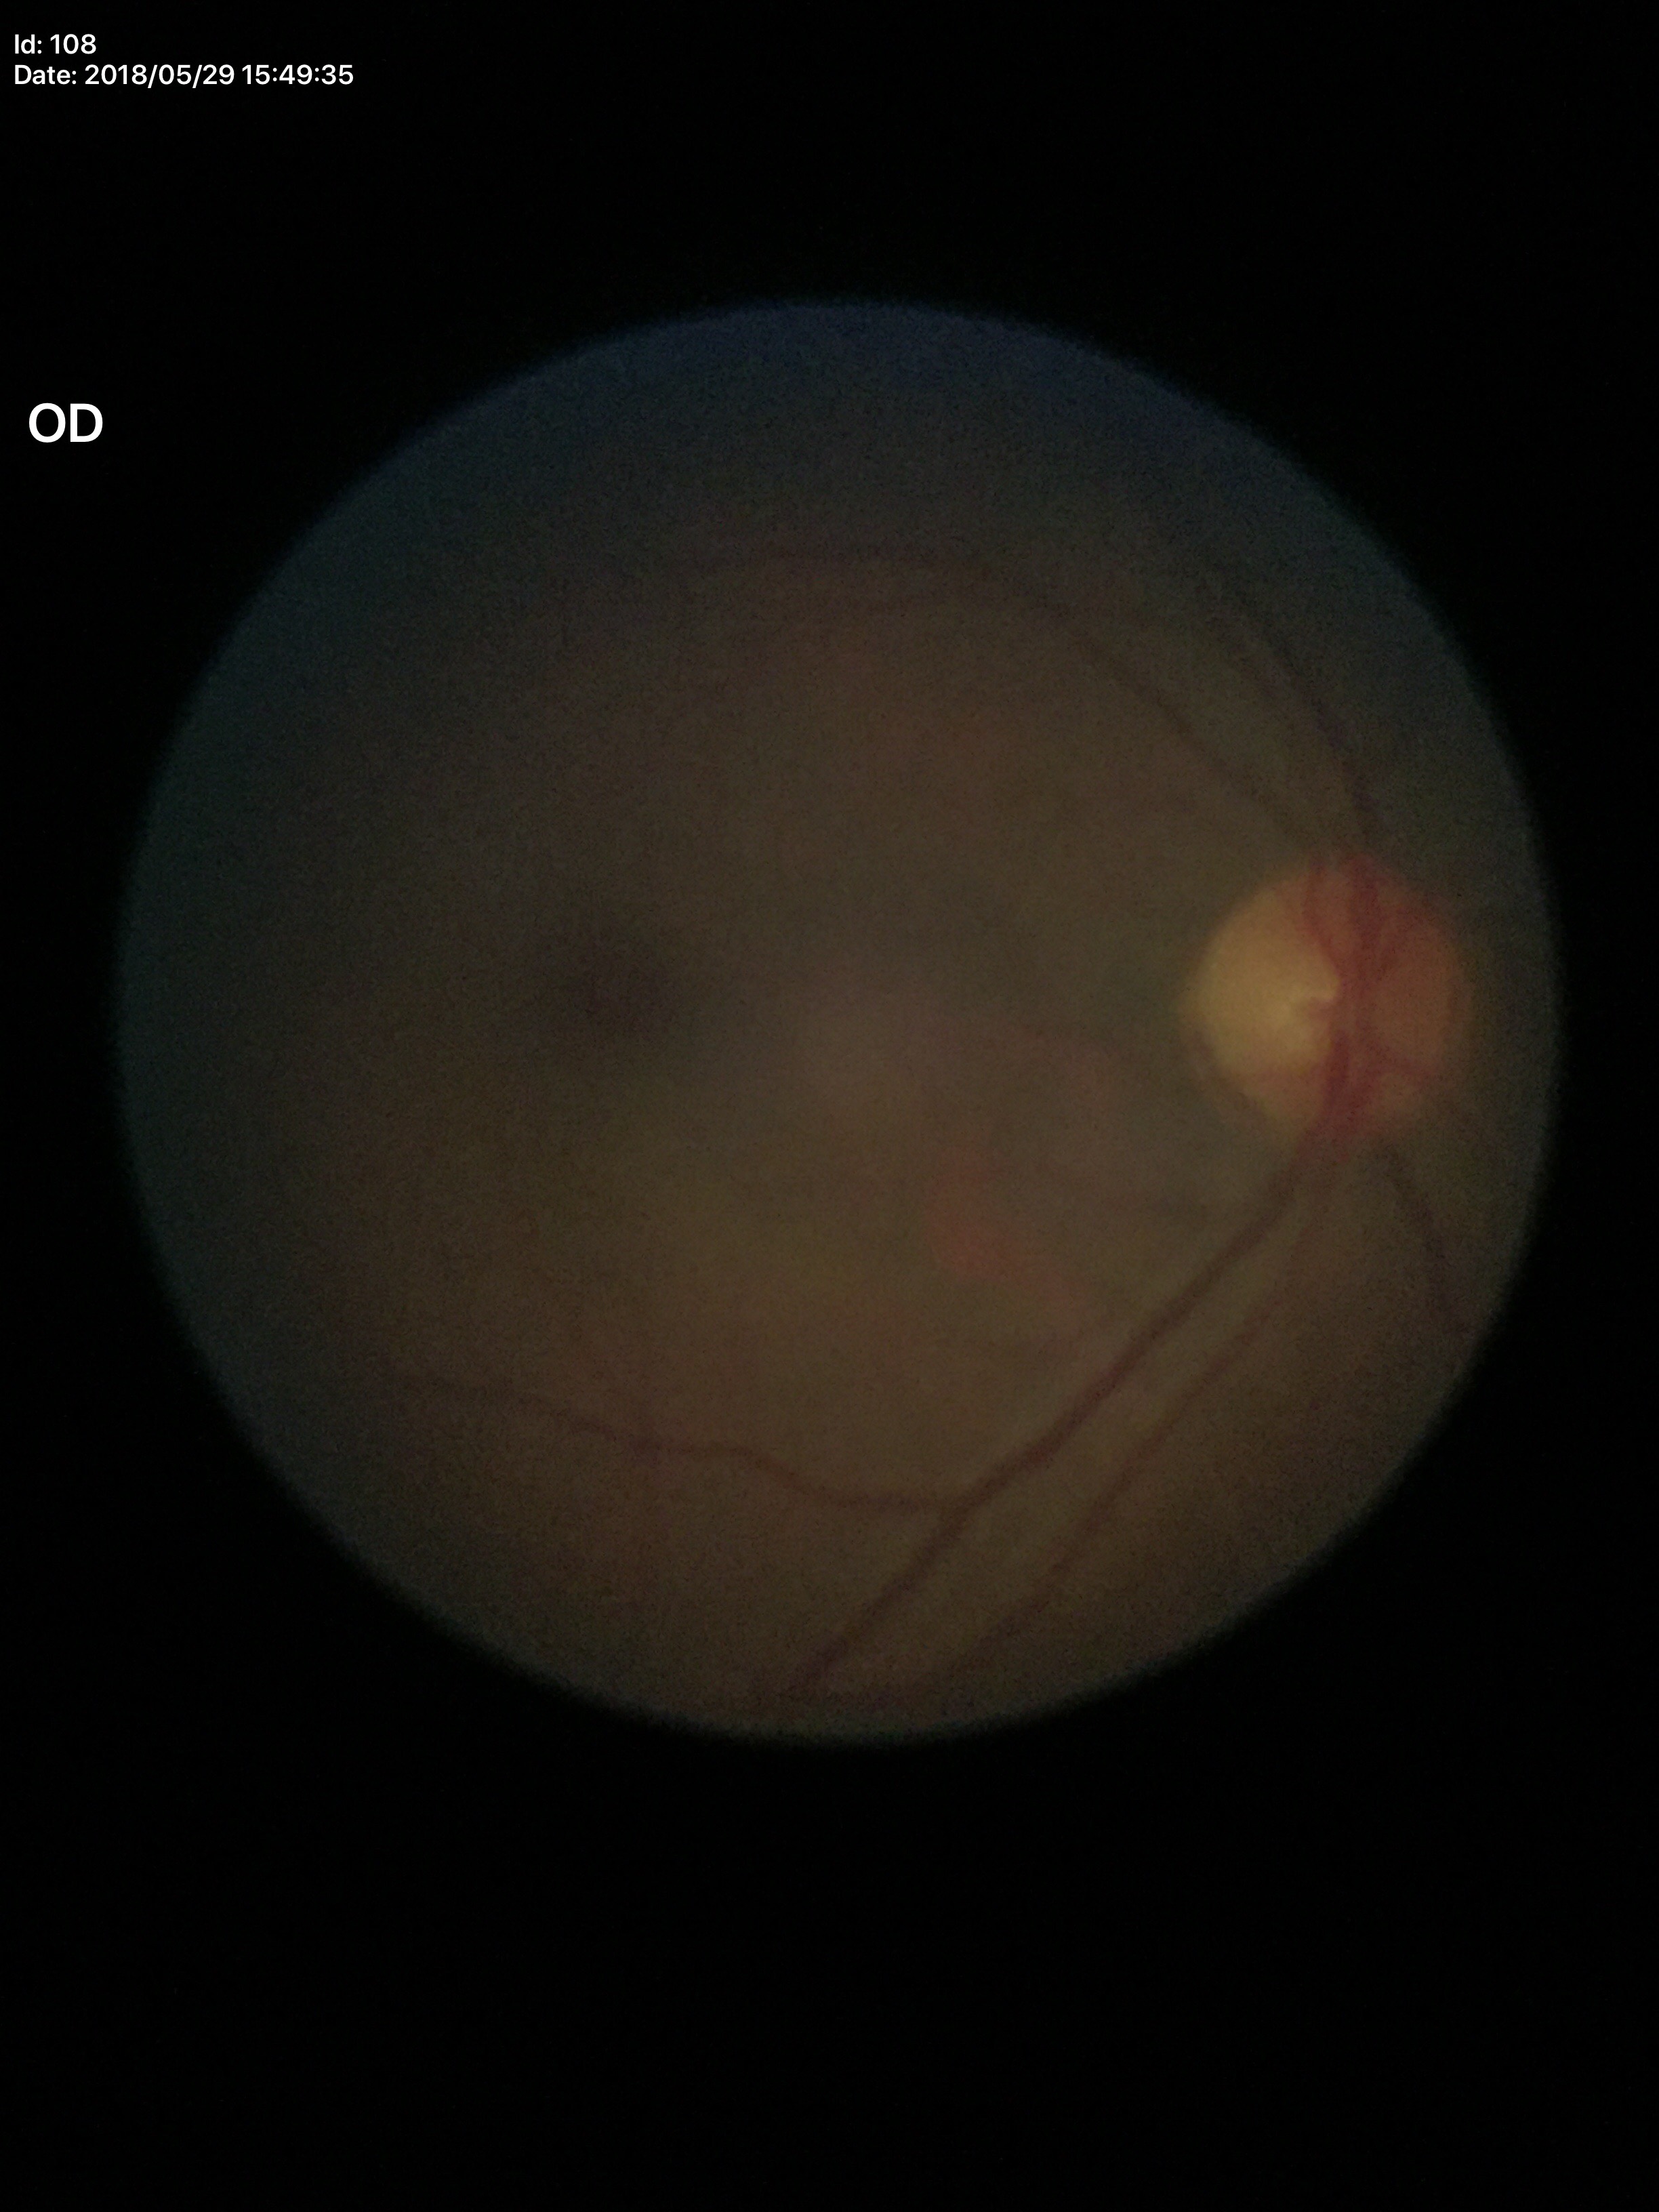
No signs of glaucoma. Vertical CDR: 0.48.